Color fundus image · 45° FOV
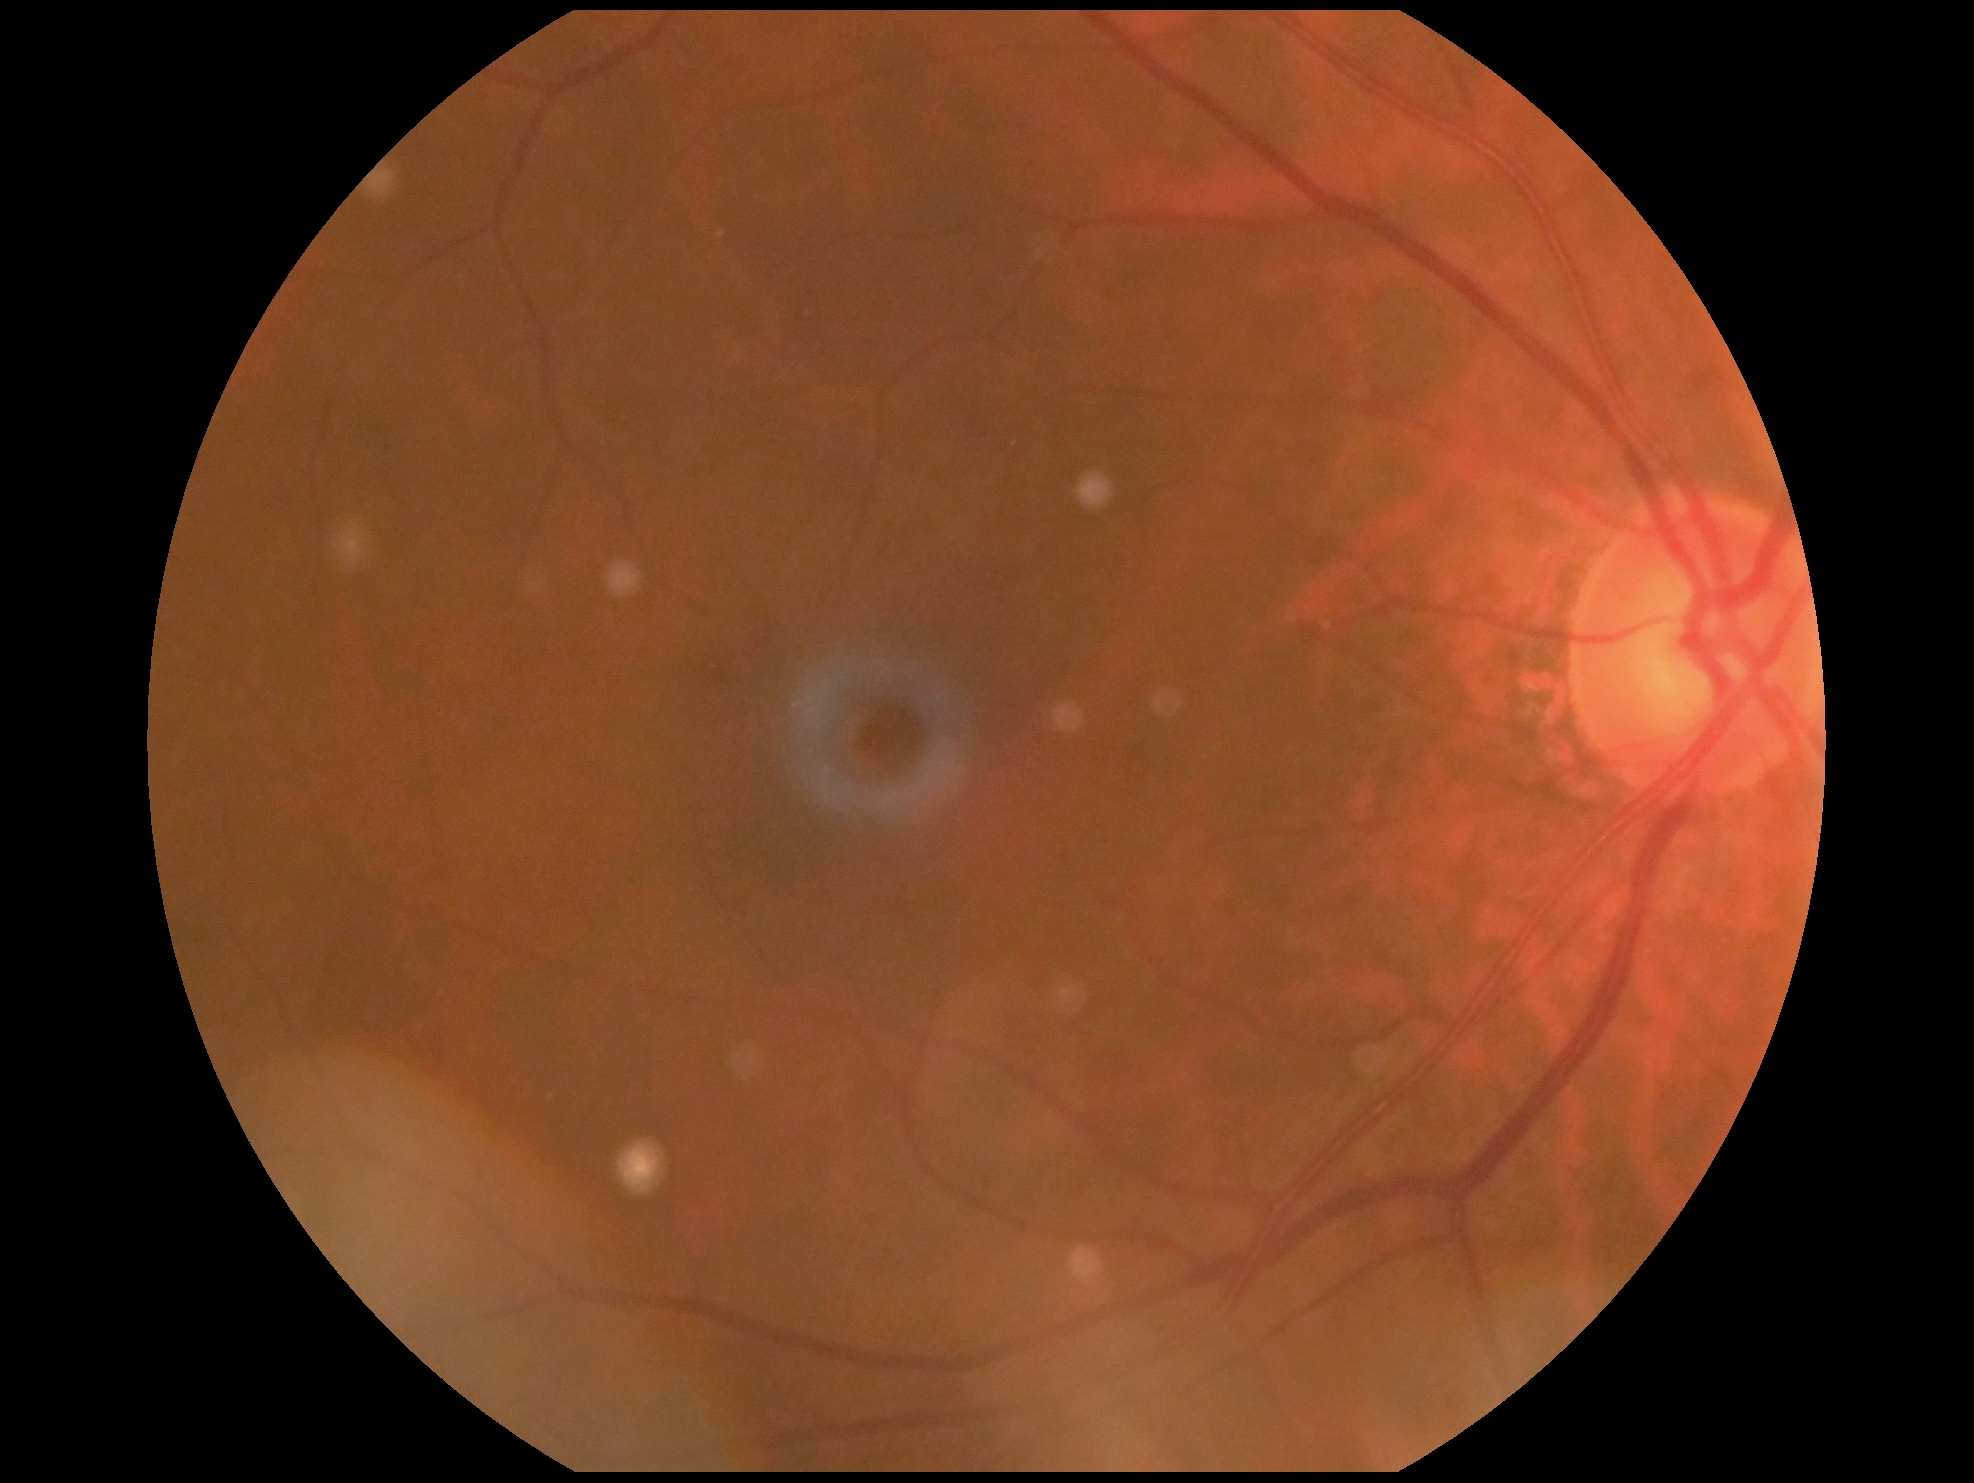
DR is grade 2 (moderate NPDR).
DR class: non-proliferative diabetic retinopathy.